Fundus photo, FOV: 45 degrees, 2212x1659:
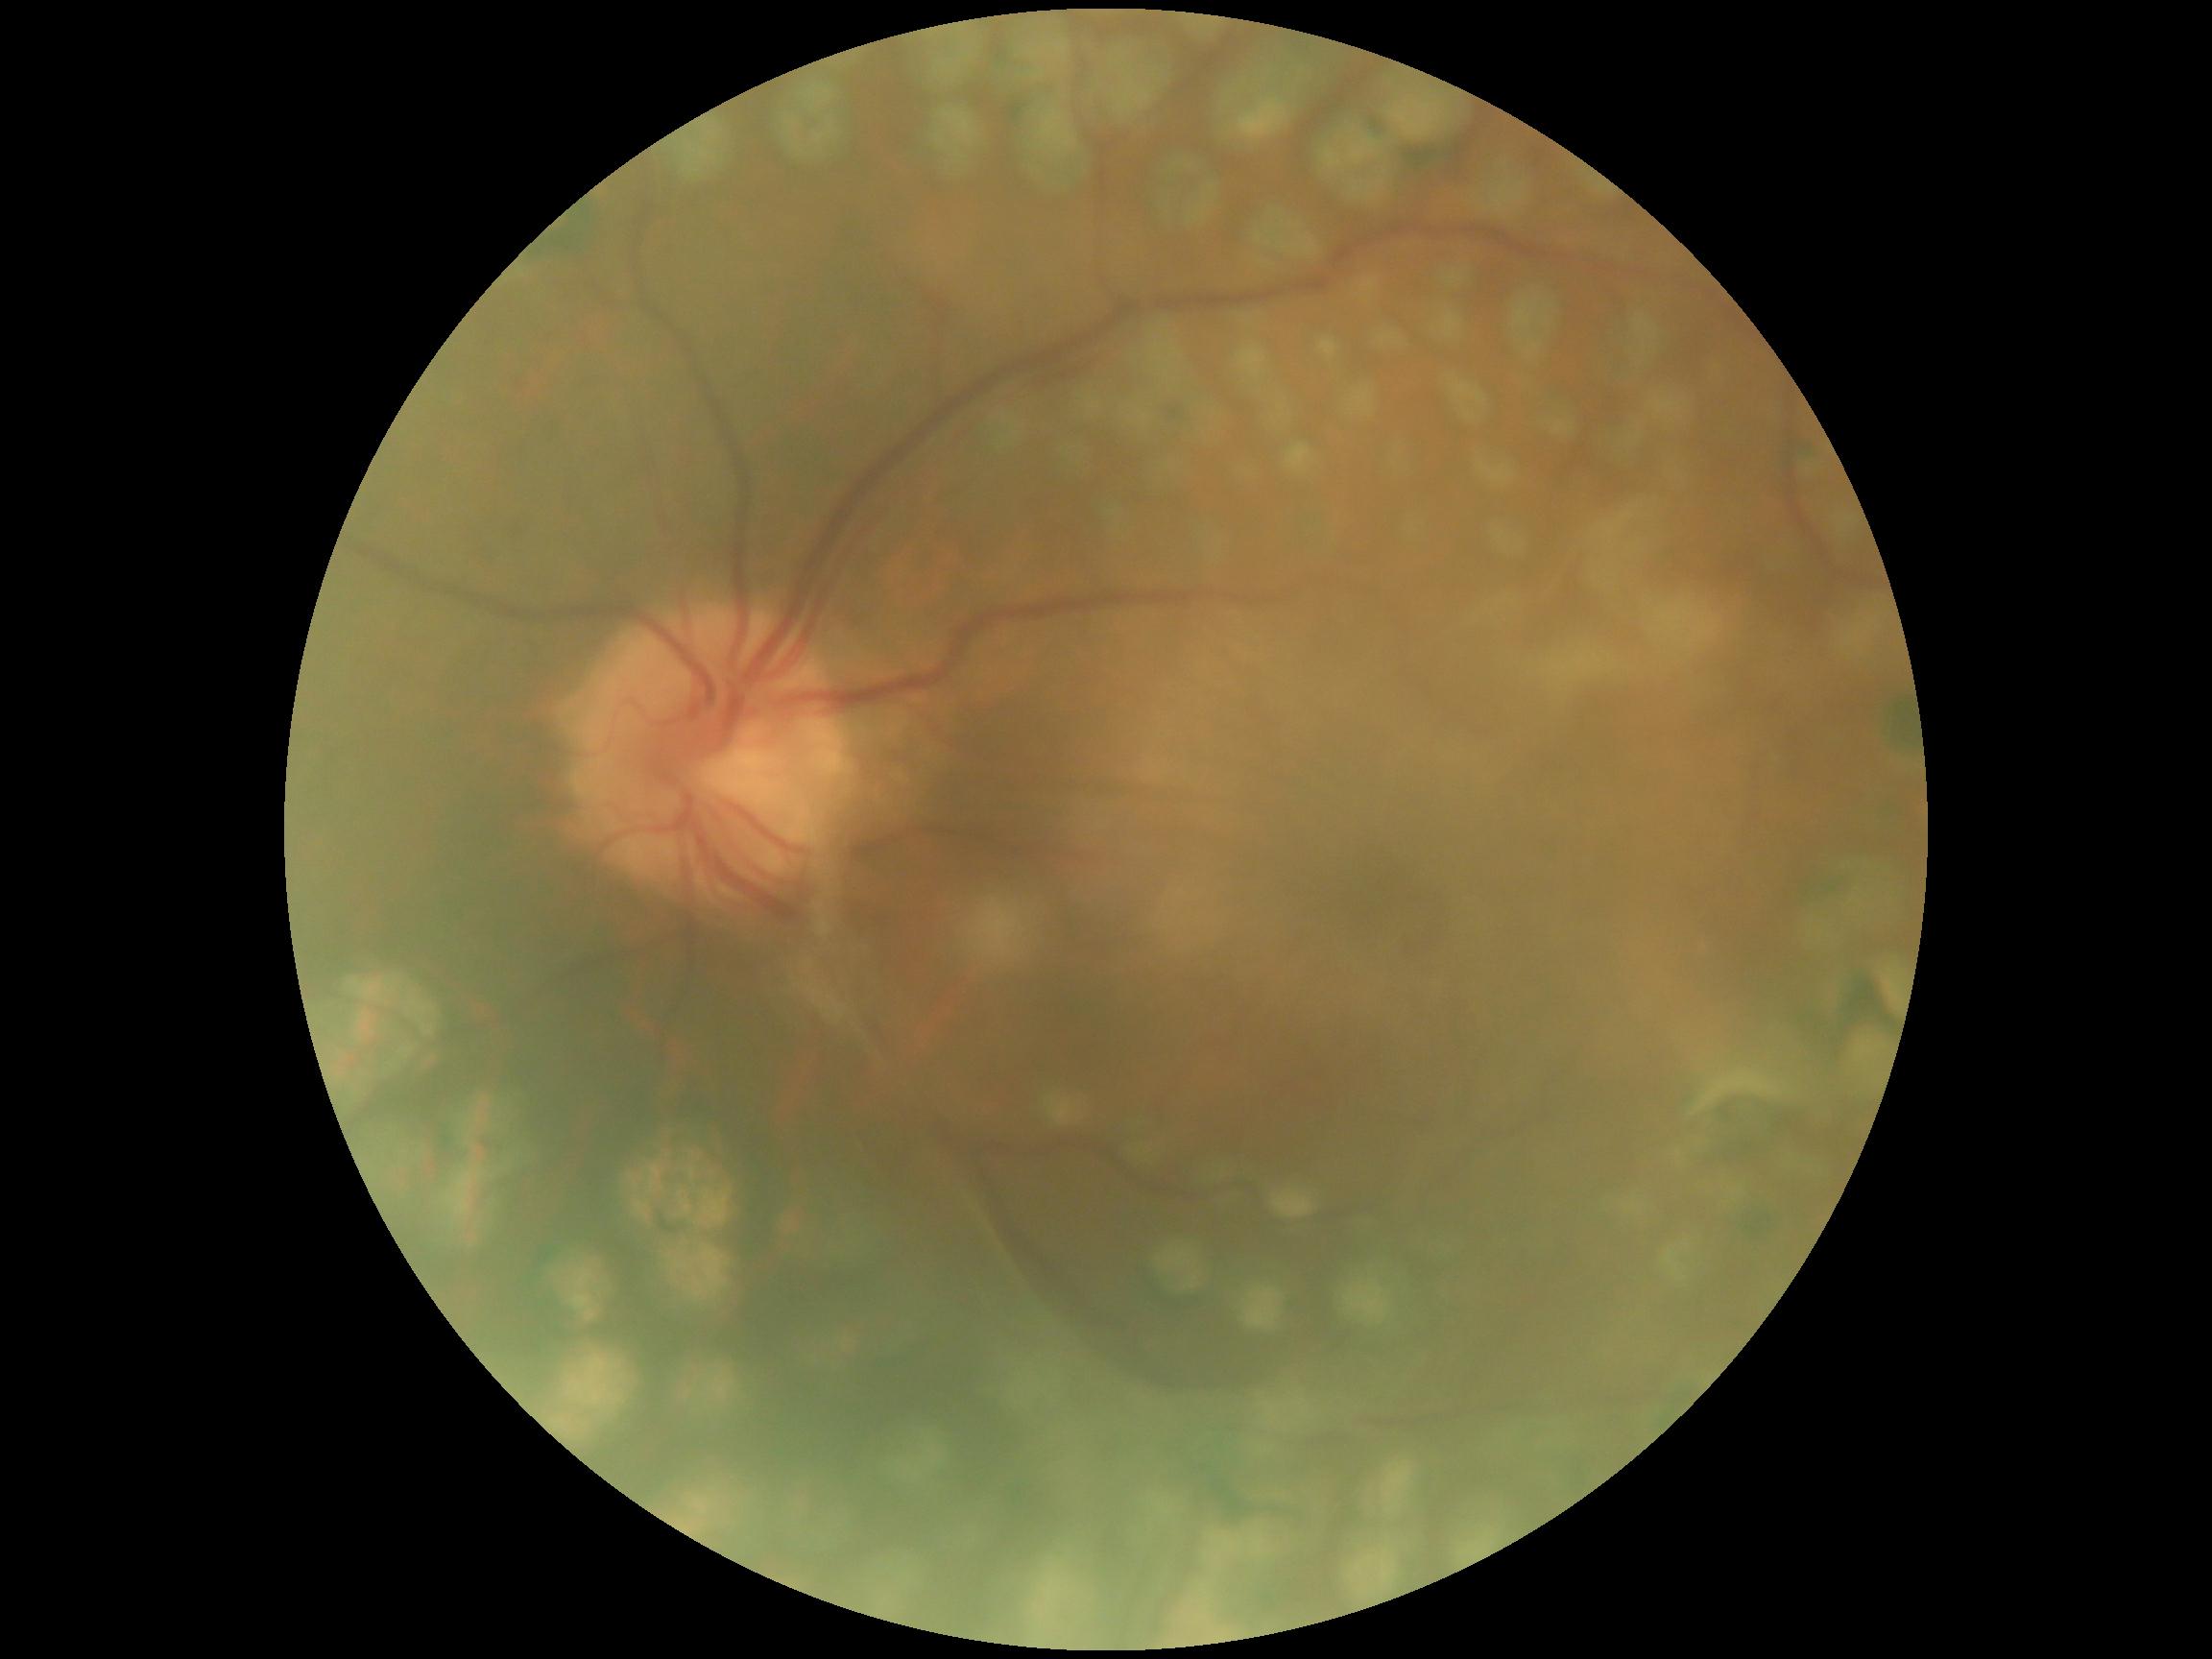
  dr_grade: grade 4 (PDR)
  dr_category: proliferative diabetic retinopathy